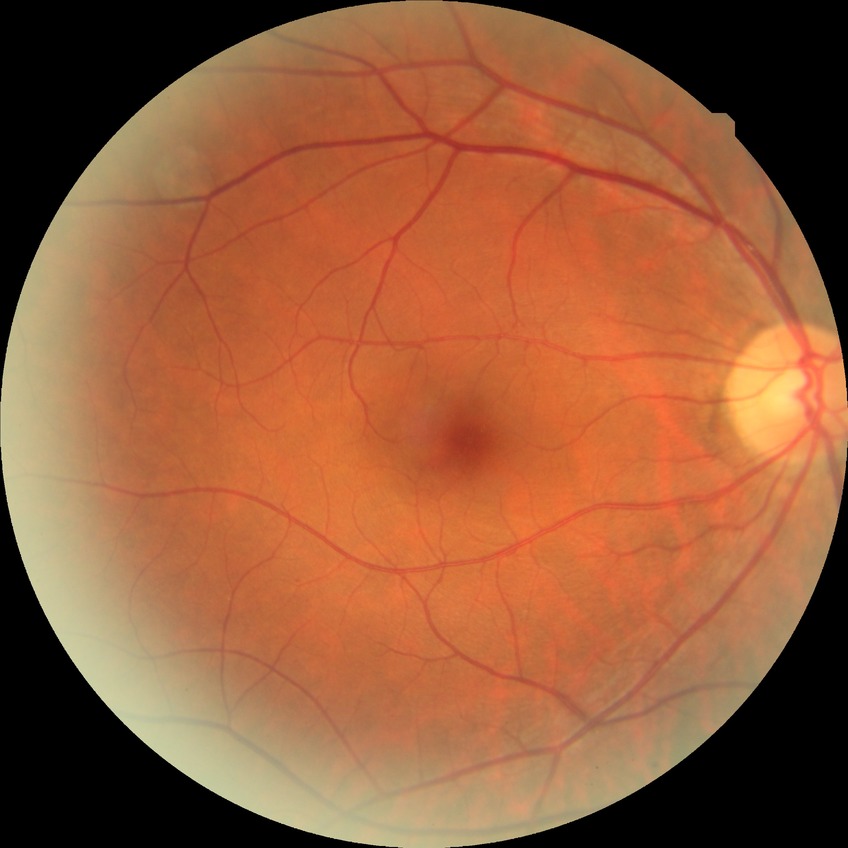

DR class: non-proliferative diabetic retinopathy, diabetic retinopathy (DR): simple diabetic retinopathy (SDR).